45° field of view · 2352 x 1568 pixels · CFP — 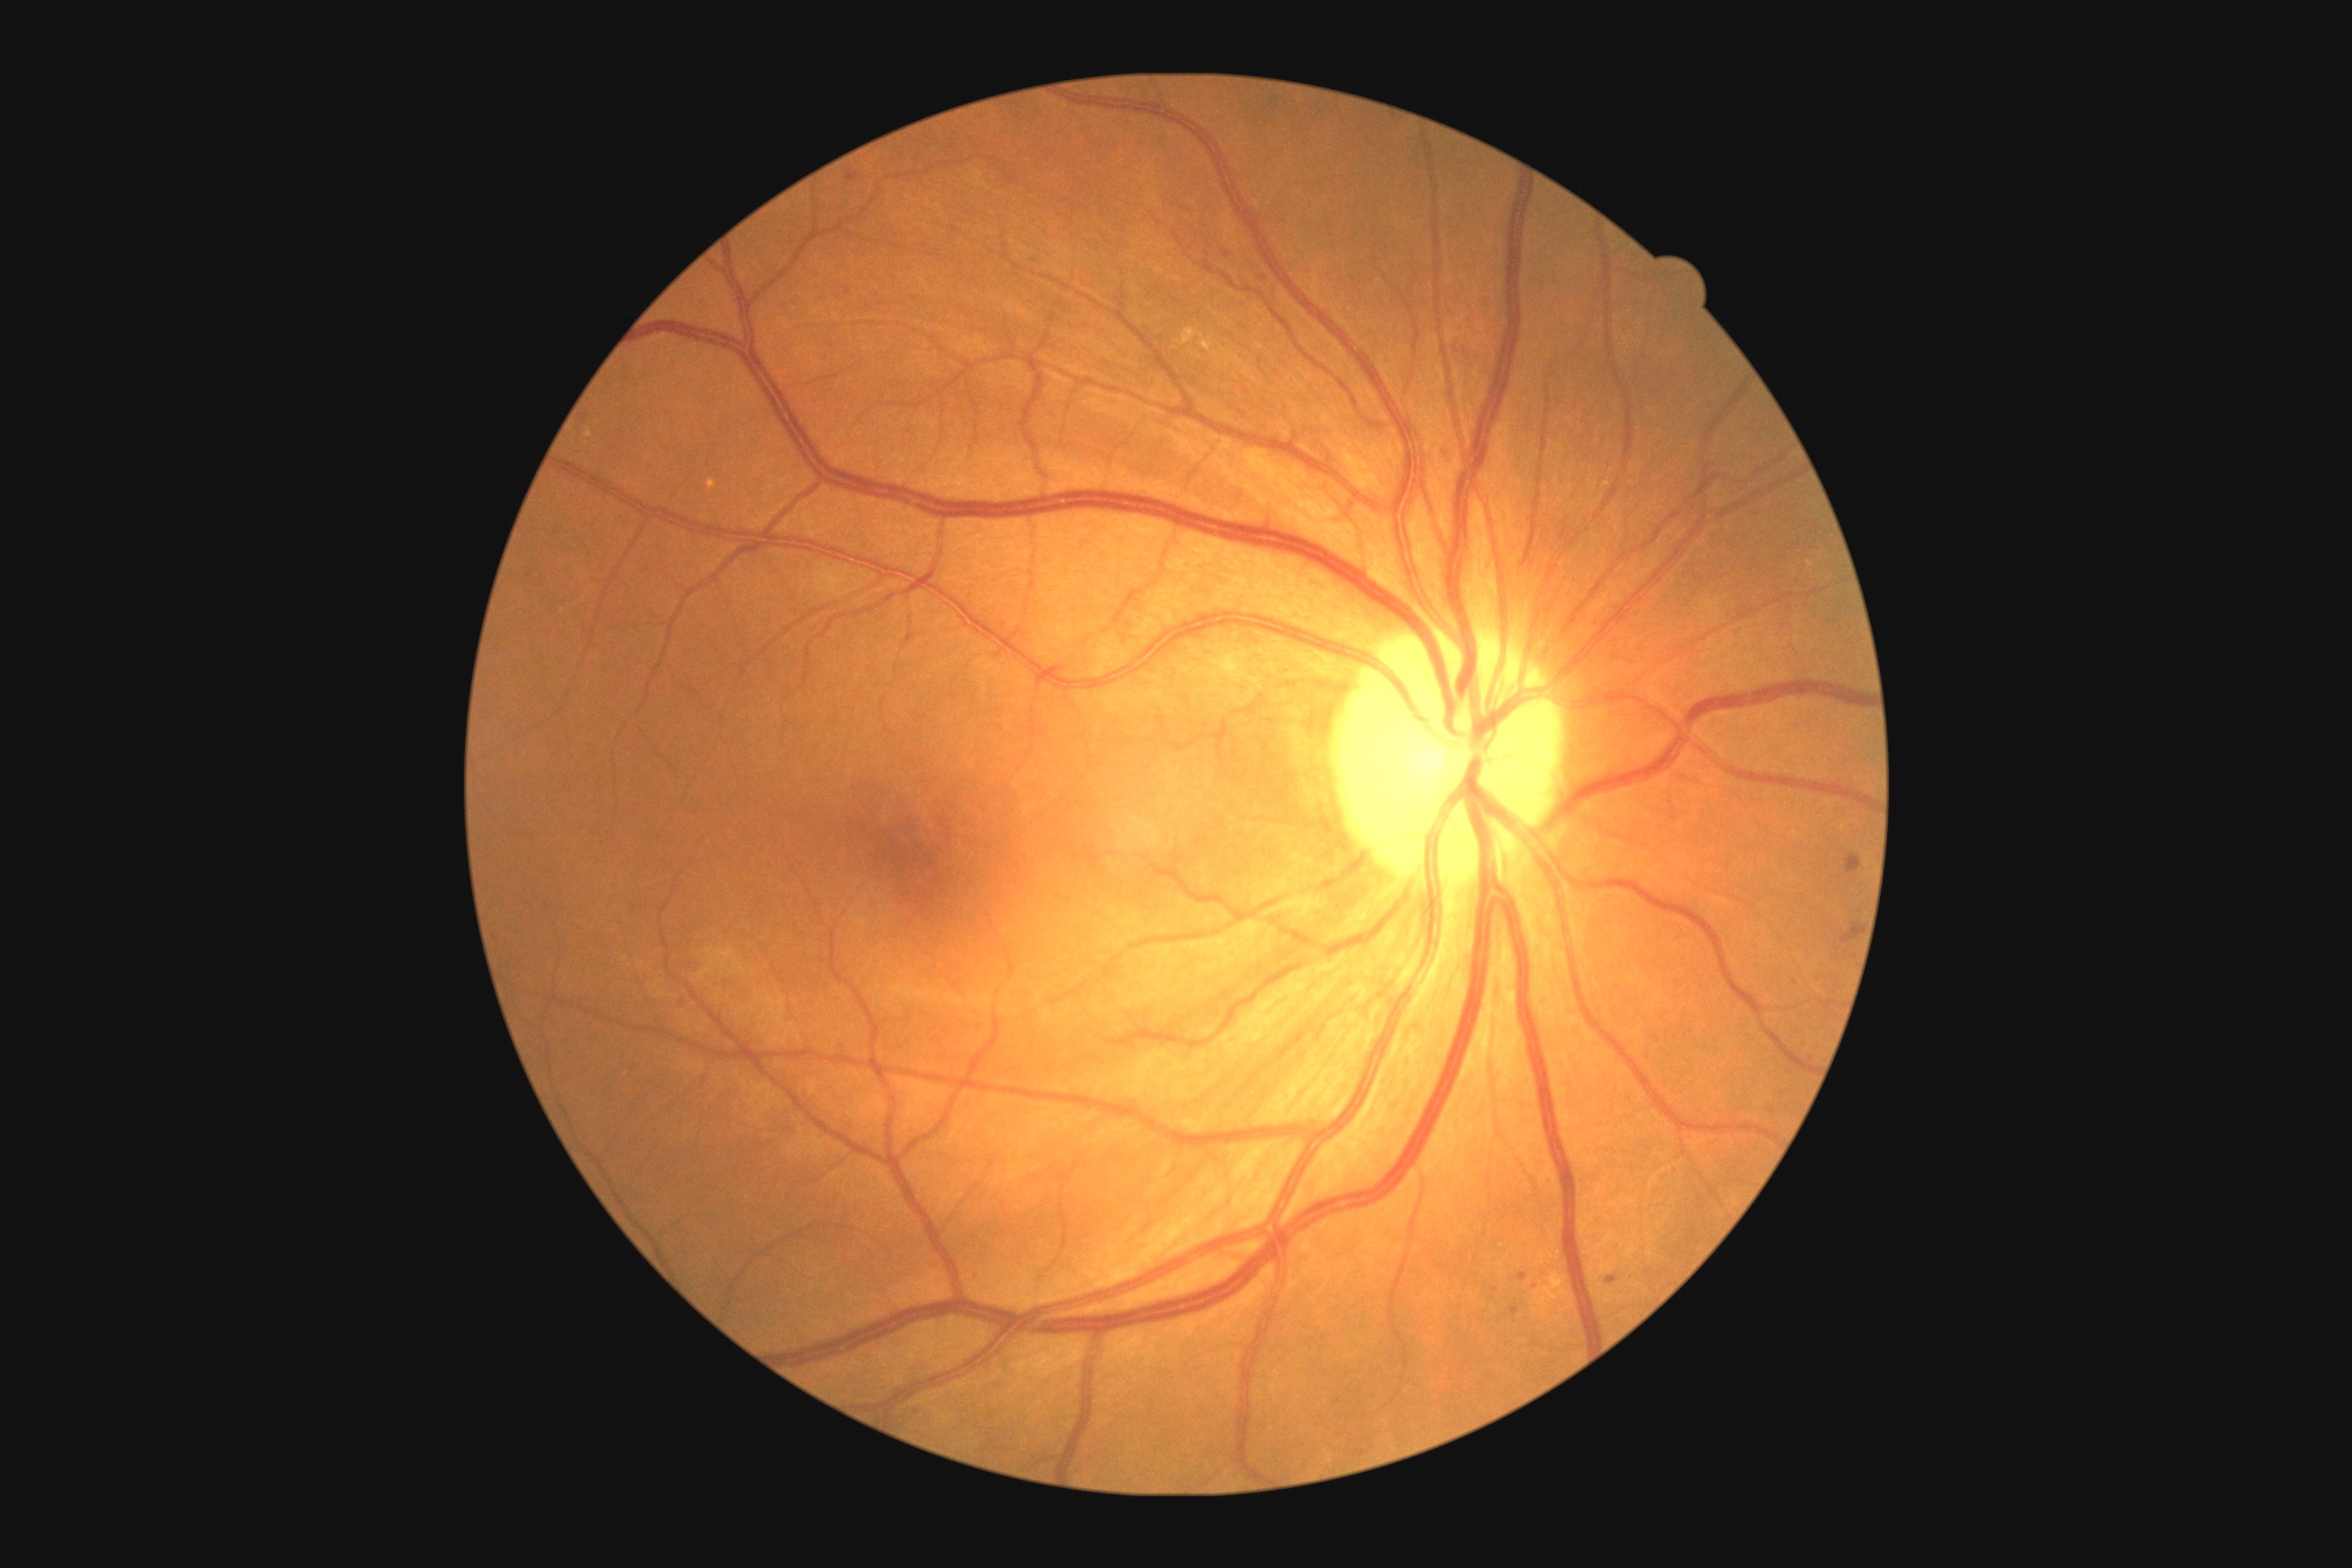 Diabetic retinopathy: 2/4
Representative lesions:
hard exudates: <box>1179,328,1233,362</box>, <box>1551,1273,1565,1286</box>, <box>585,431,593,438</box>
microaneurysms (subset): <box>1607,1277,1616,1284</box>, <box>672,997,689,1014</box>, <box>847,172,861,182</box>, <box>1560,531,1567,542</box>, <box>1518,1273,1529,1282</box>, <box>1841,921,1861,945</box>
Small microaneurysms near (1491; 1299), (1227; 256), (1264; 278), (727; 984), (1514; 1311), (1495; 1290), (1033; 260)
soft exudates: none
hemorrhages: none